Retinal fundus photograph; image size 848x848; 45 degree fundus photograph.
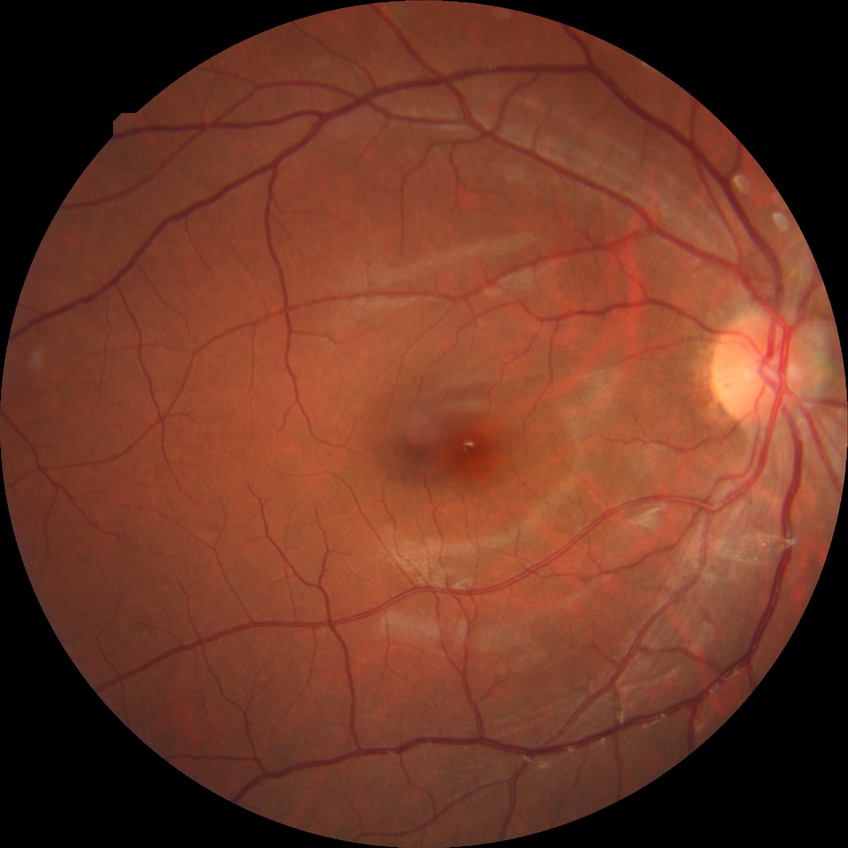

DR stage: NDR.